1932x1923.
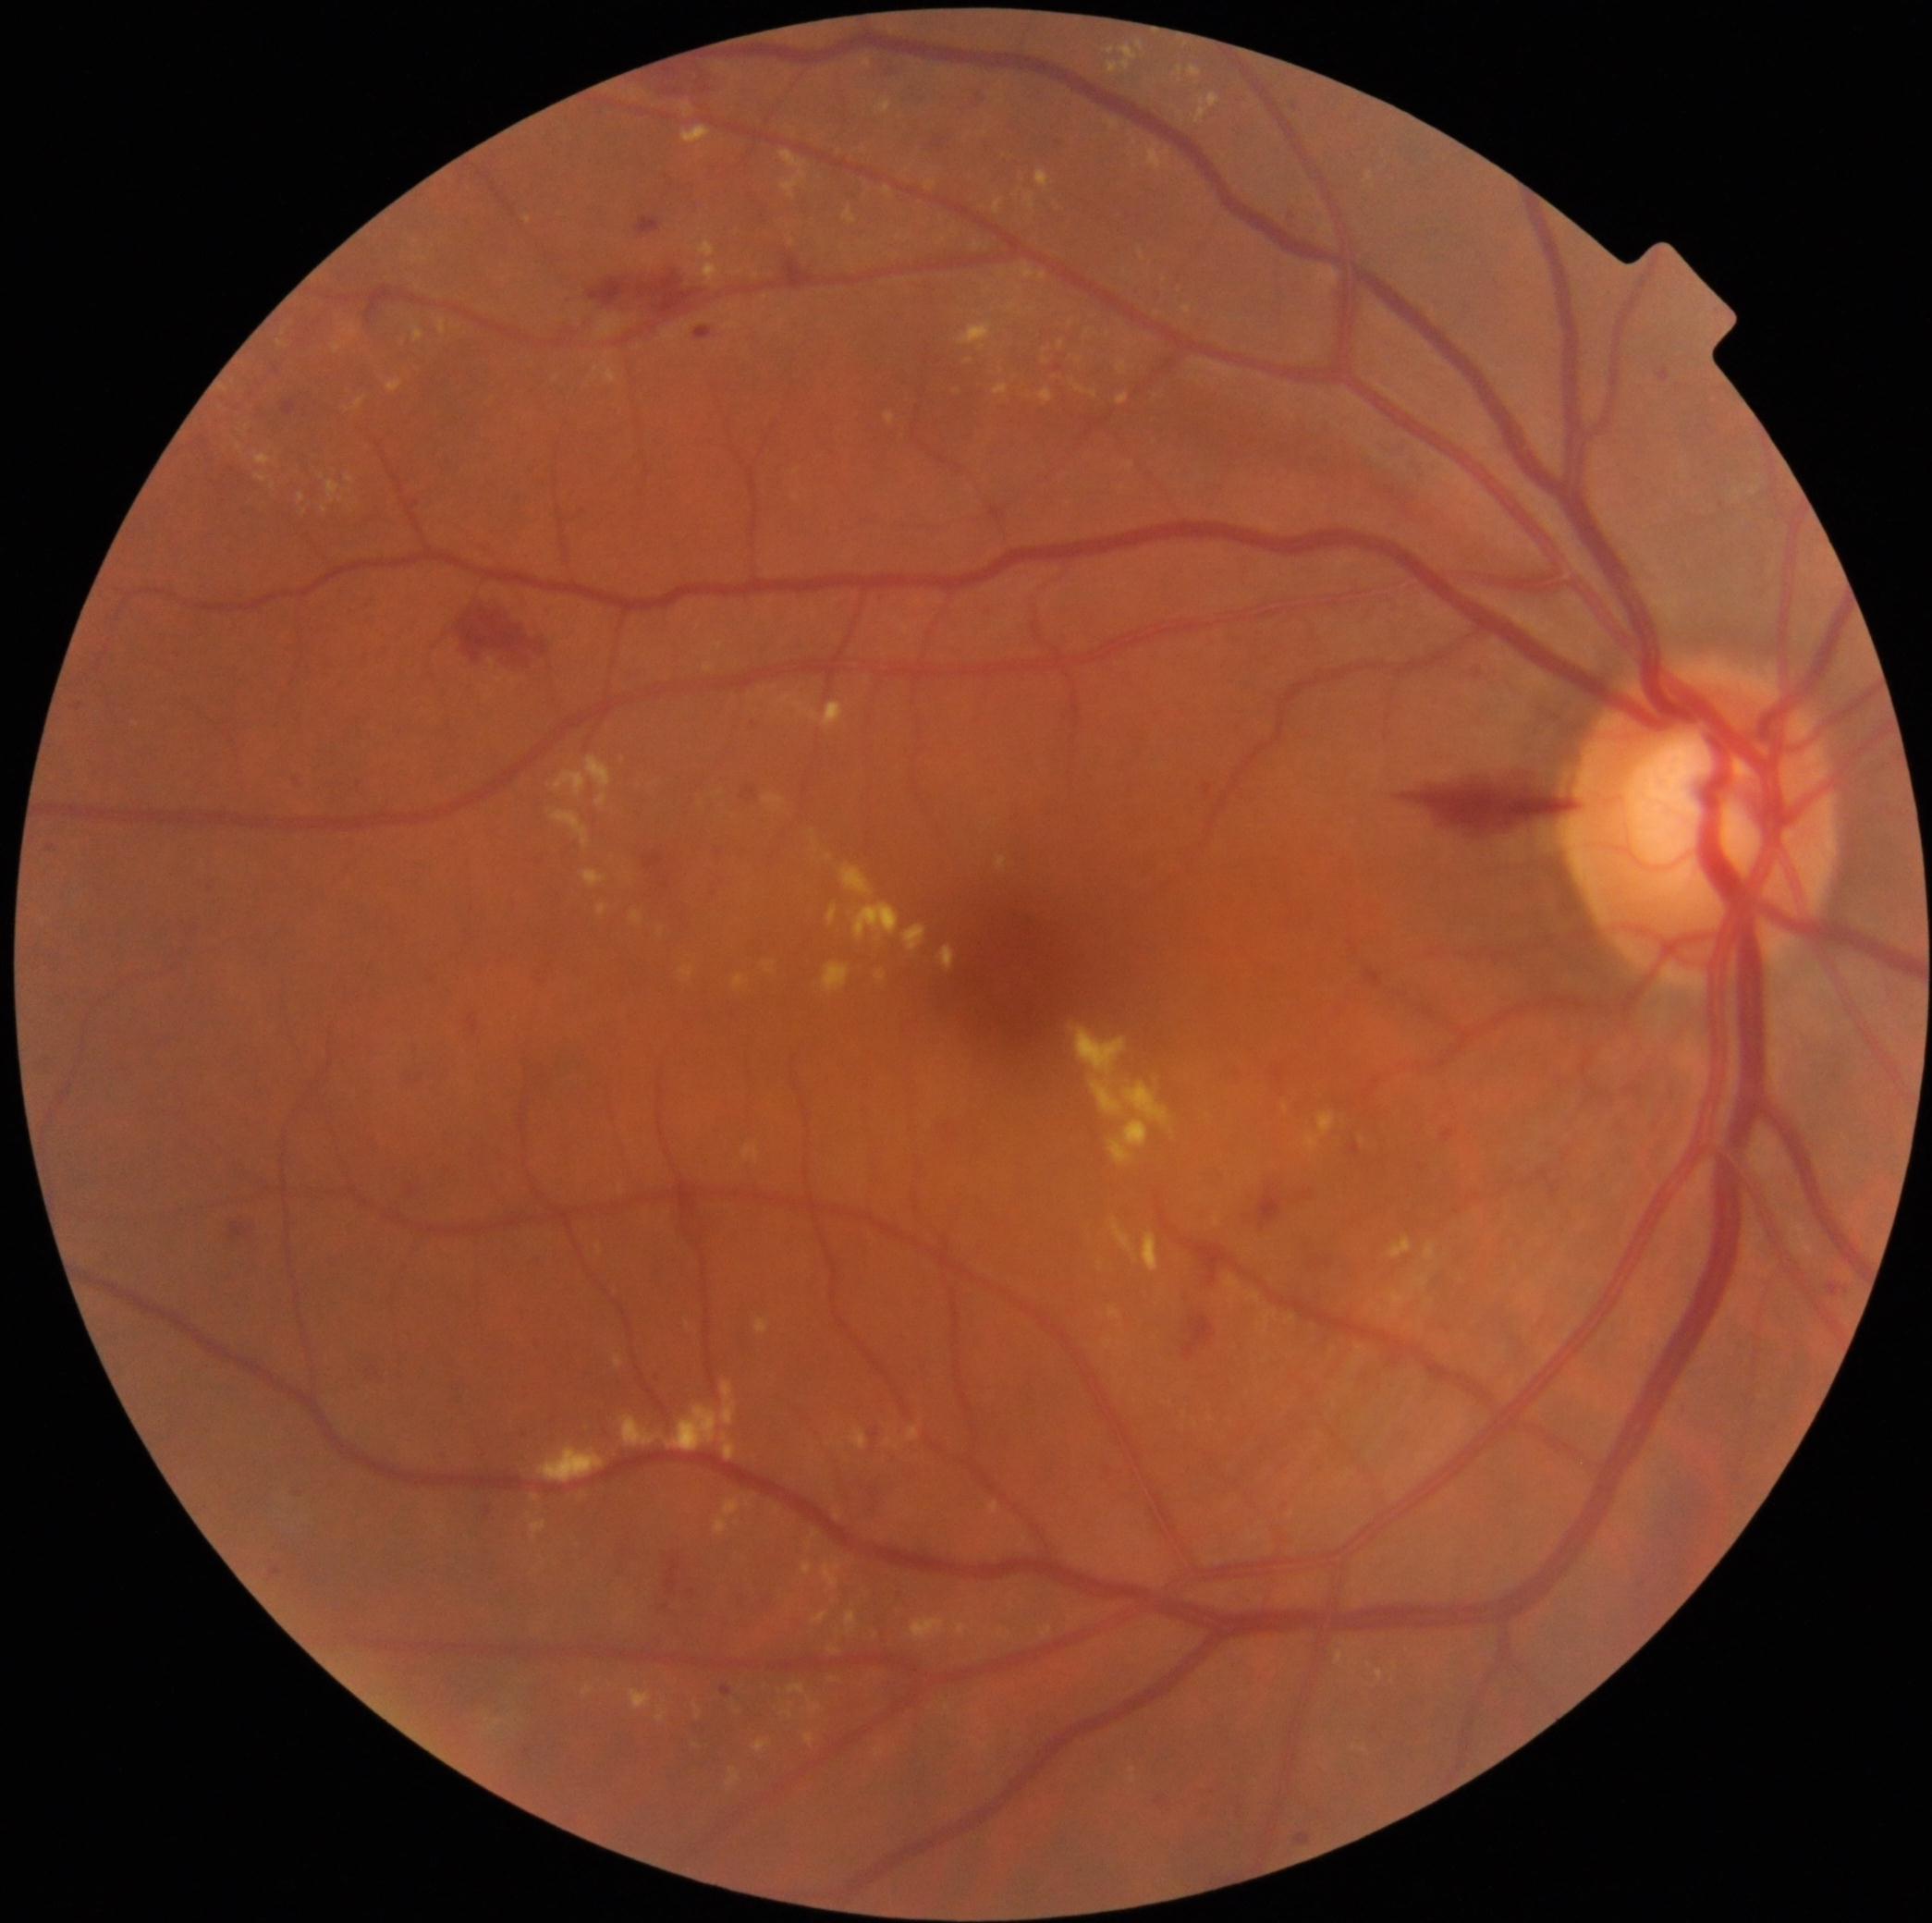

DR severity is moderate non-proliferative diabetic retinopathy (grade 2). EXs include lesions at 594 352 619 385 | 1335 1649 1346 1665 | 439 319 446 336 | 765 961 776 974 | 877 971 887 982 | 326 480 342 505 | 299 493 306 504 | 554 375 561 383 | 844 209 857 226 | 1304 1110 1337 1152 | 344 489 353 493 | 715 1519 729 1536 | 1258 1311 1278 1335. Small EXs approximately at point(1187, 45) | point(1020, 315) | point(1354, 1661) | point(273, 487) | point(1012, 1607) | point(792, 243).